Image size 2212x1659. 45-degree field of view. CFP:
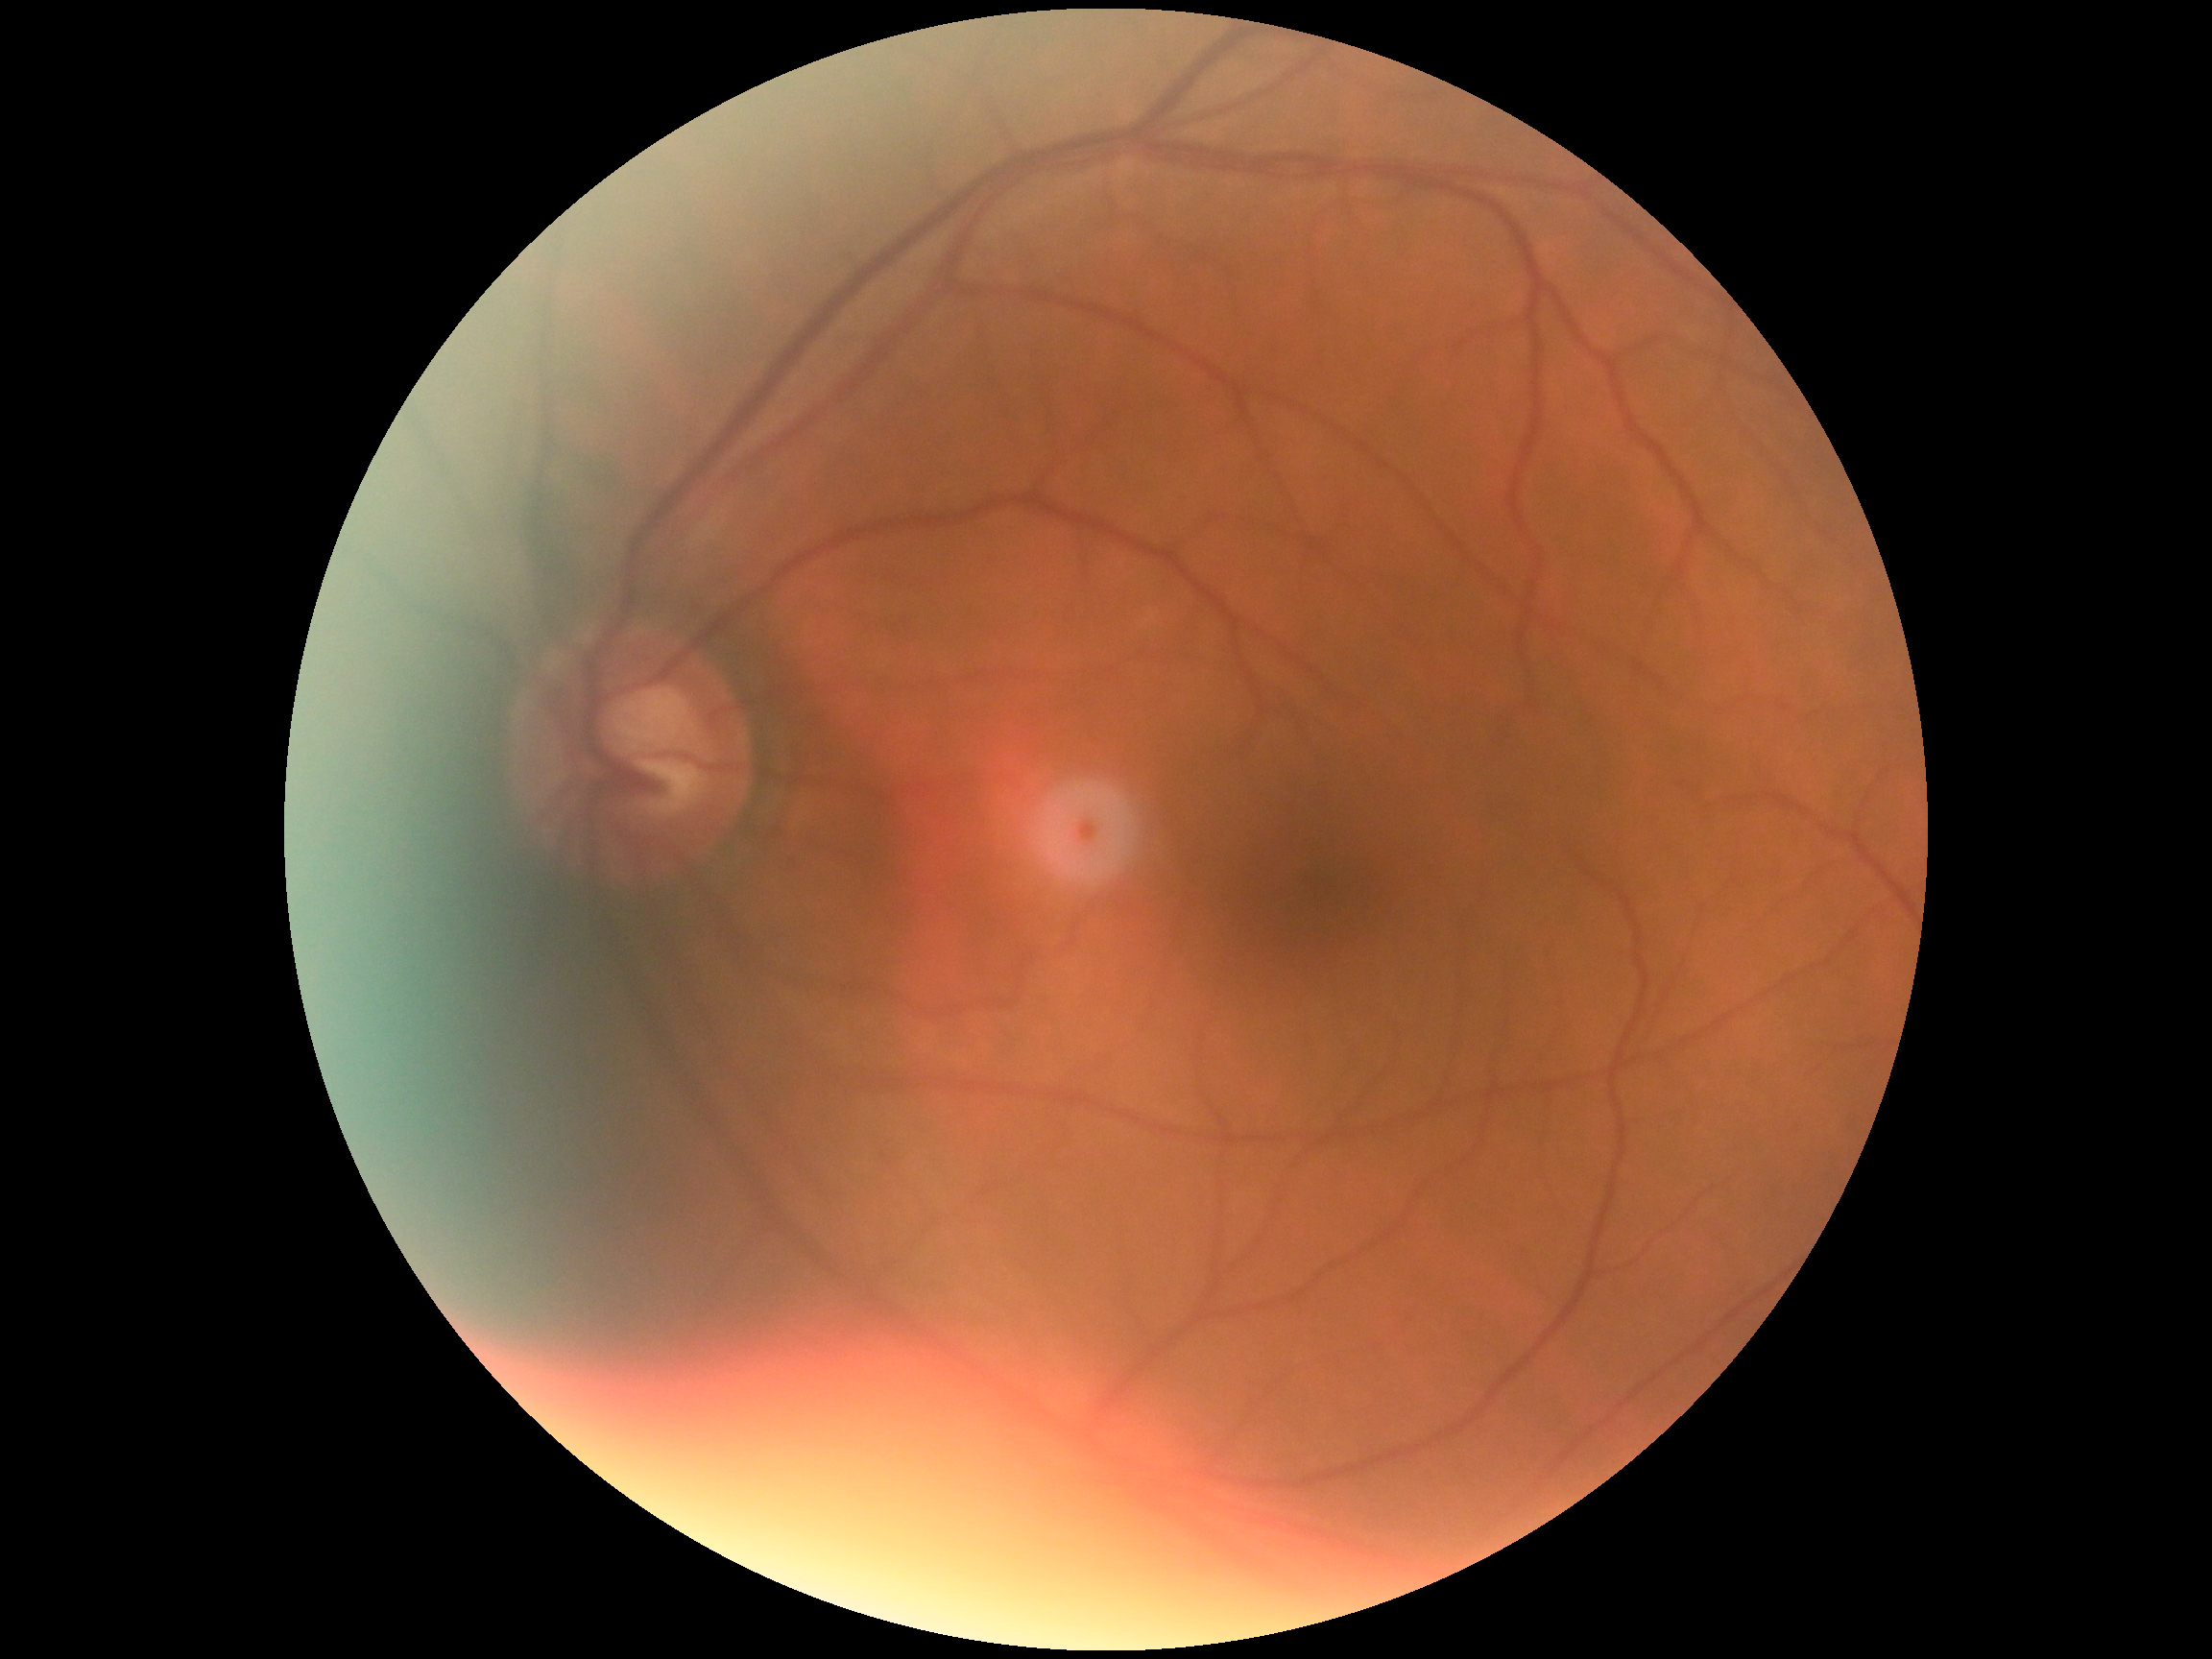

DR grade = 0 — no visible signs of diabetic retinopathy.